Pediatric wide-field fundus photograph · 1240x1240 · Phoenix ICON, 100° FOV: 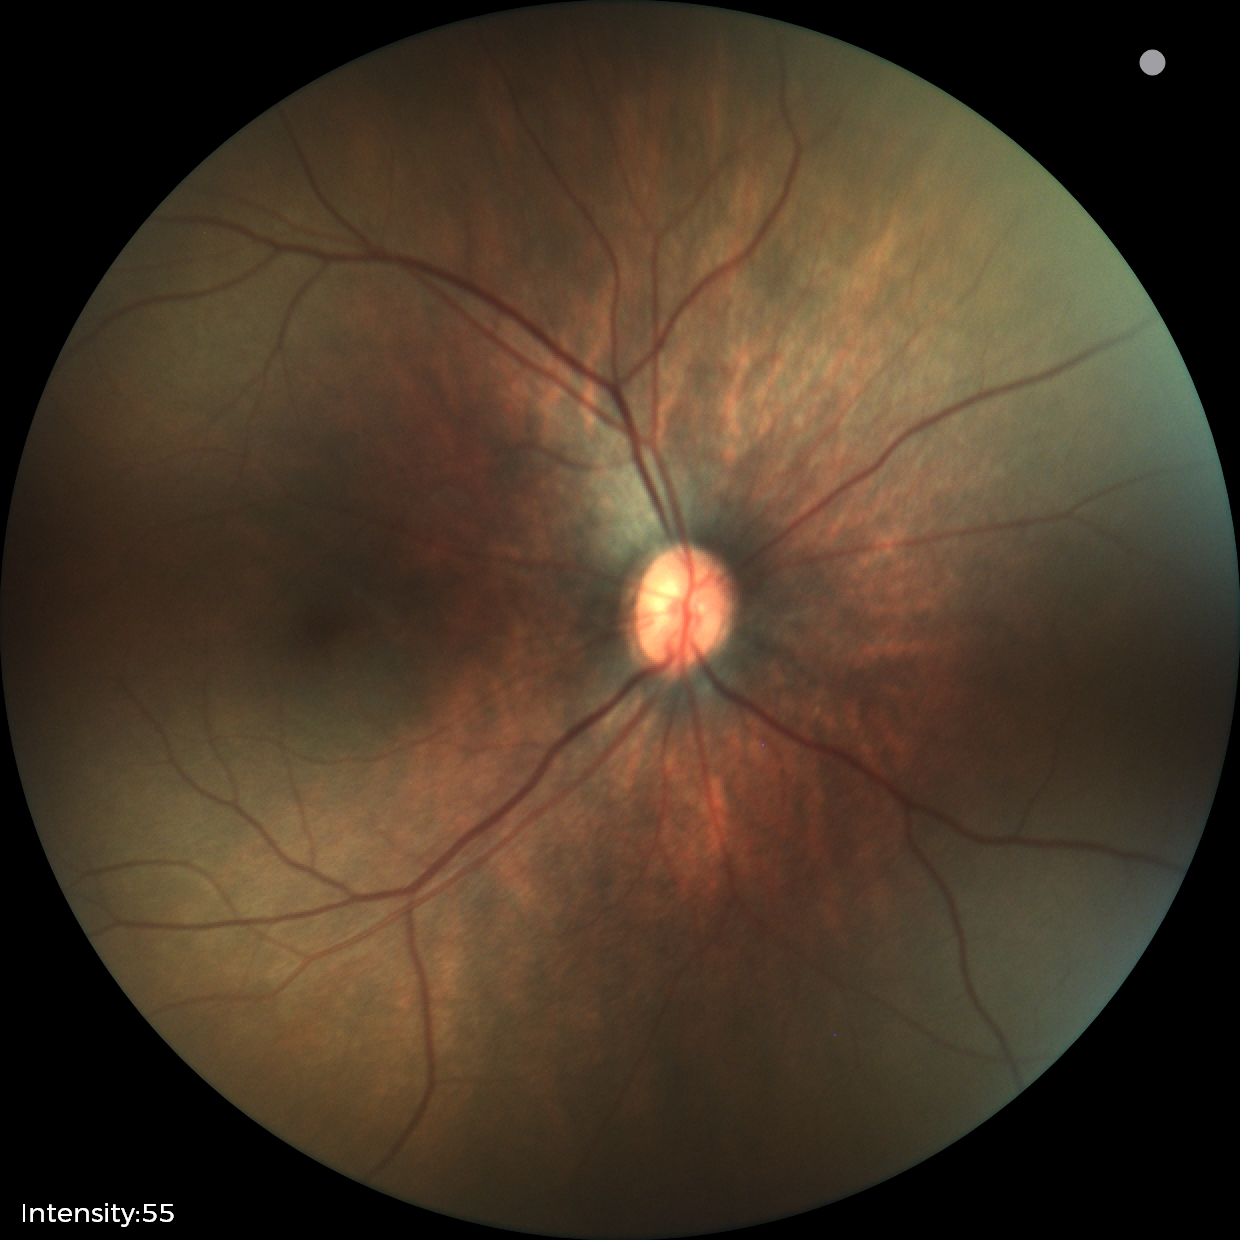 Screening examination with no abnormal retinal findings.